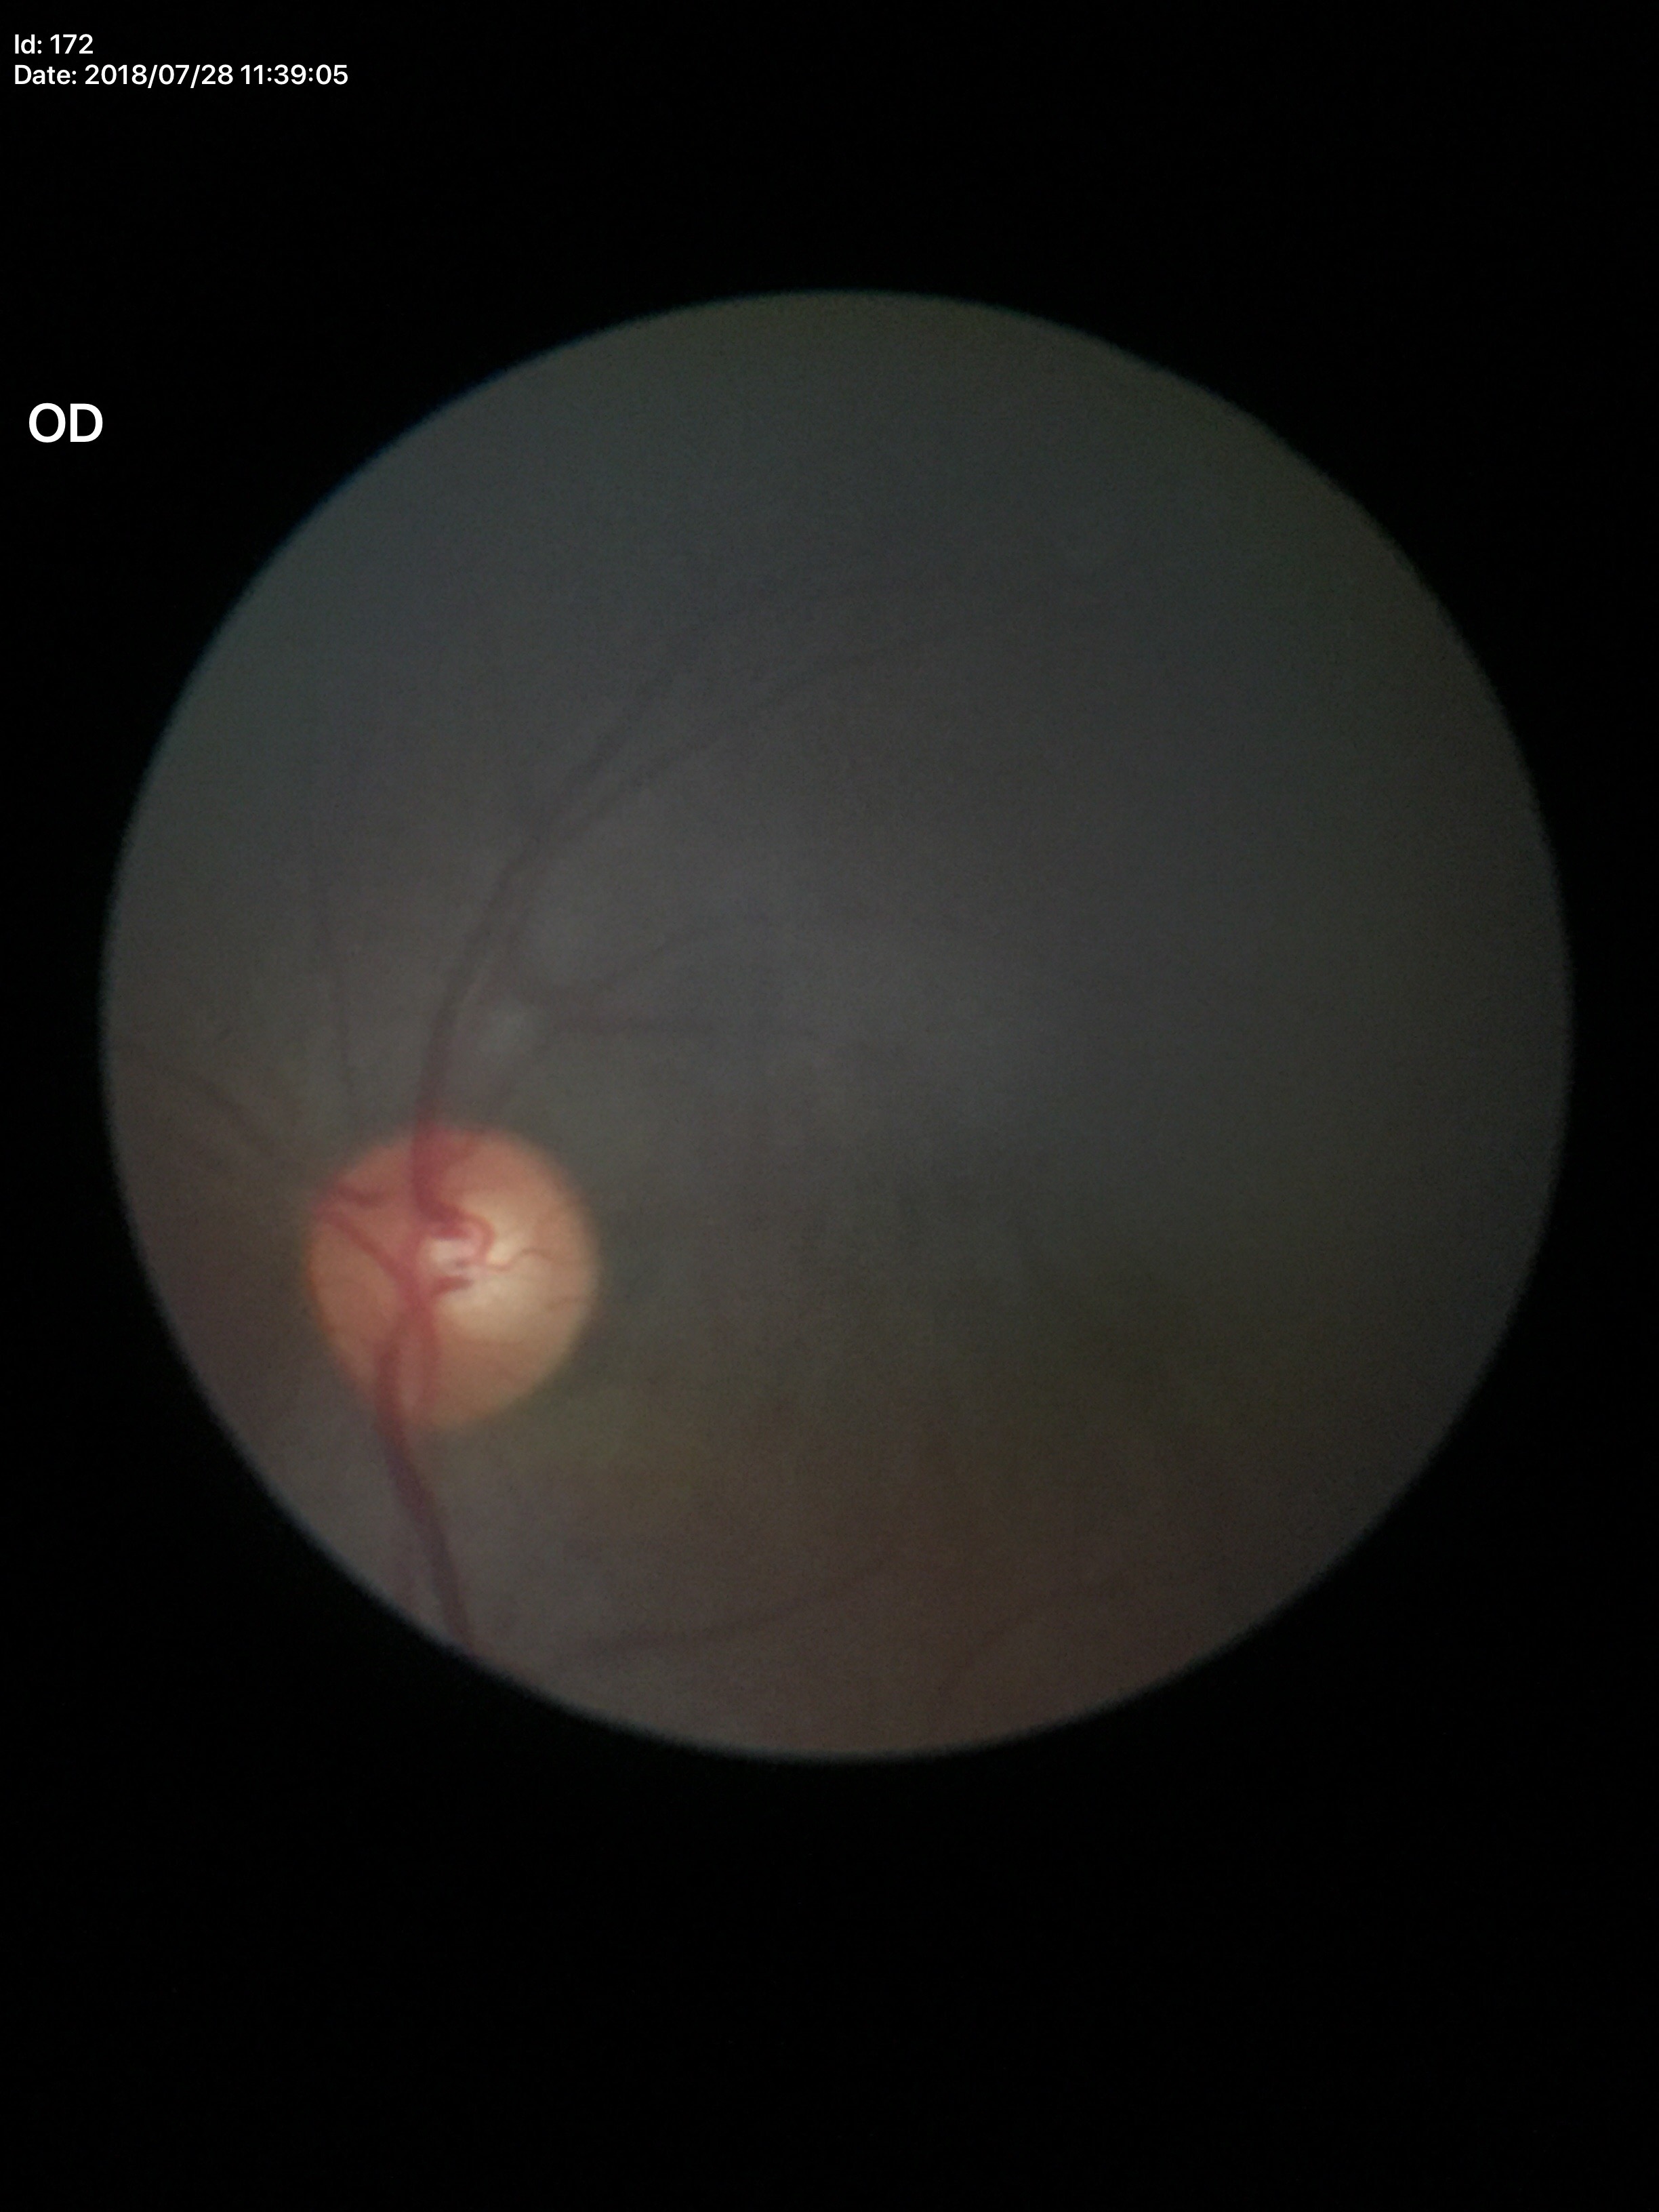   glaucoma_decision: no suspicious findings
  vcdr: 0.51
  hcdr: 0.54